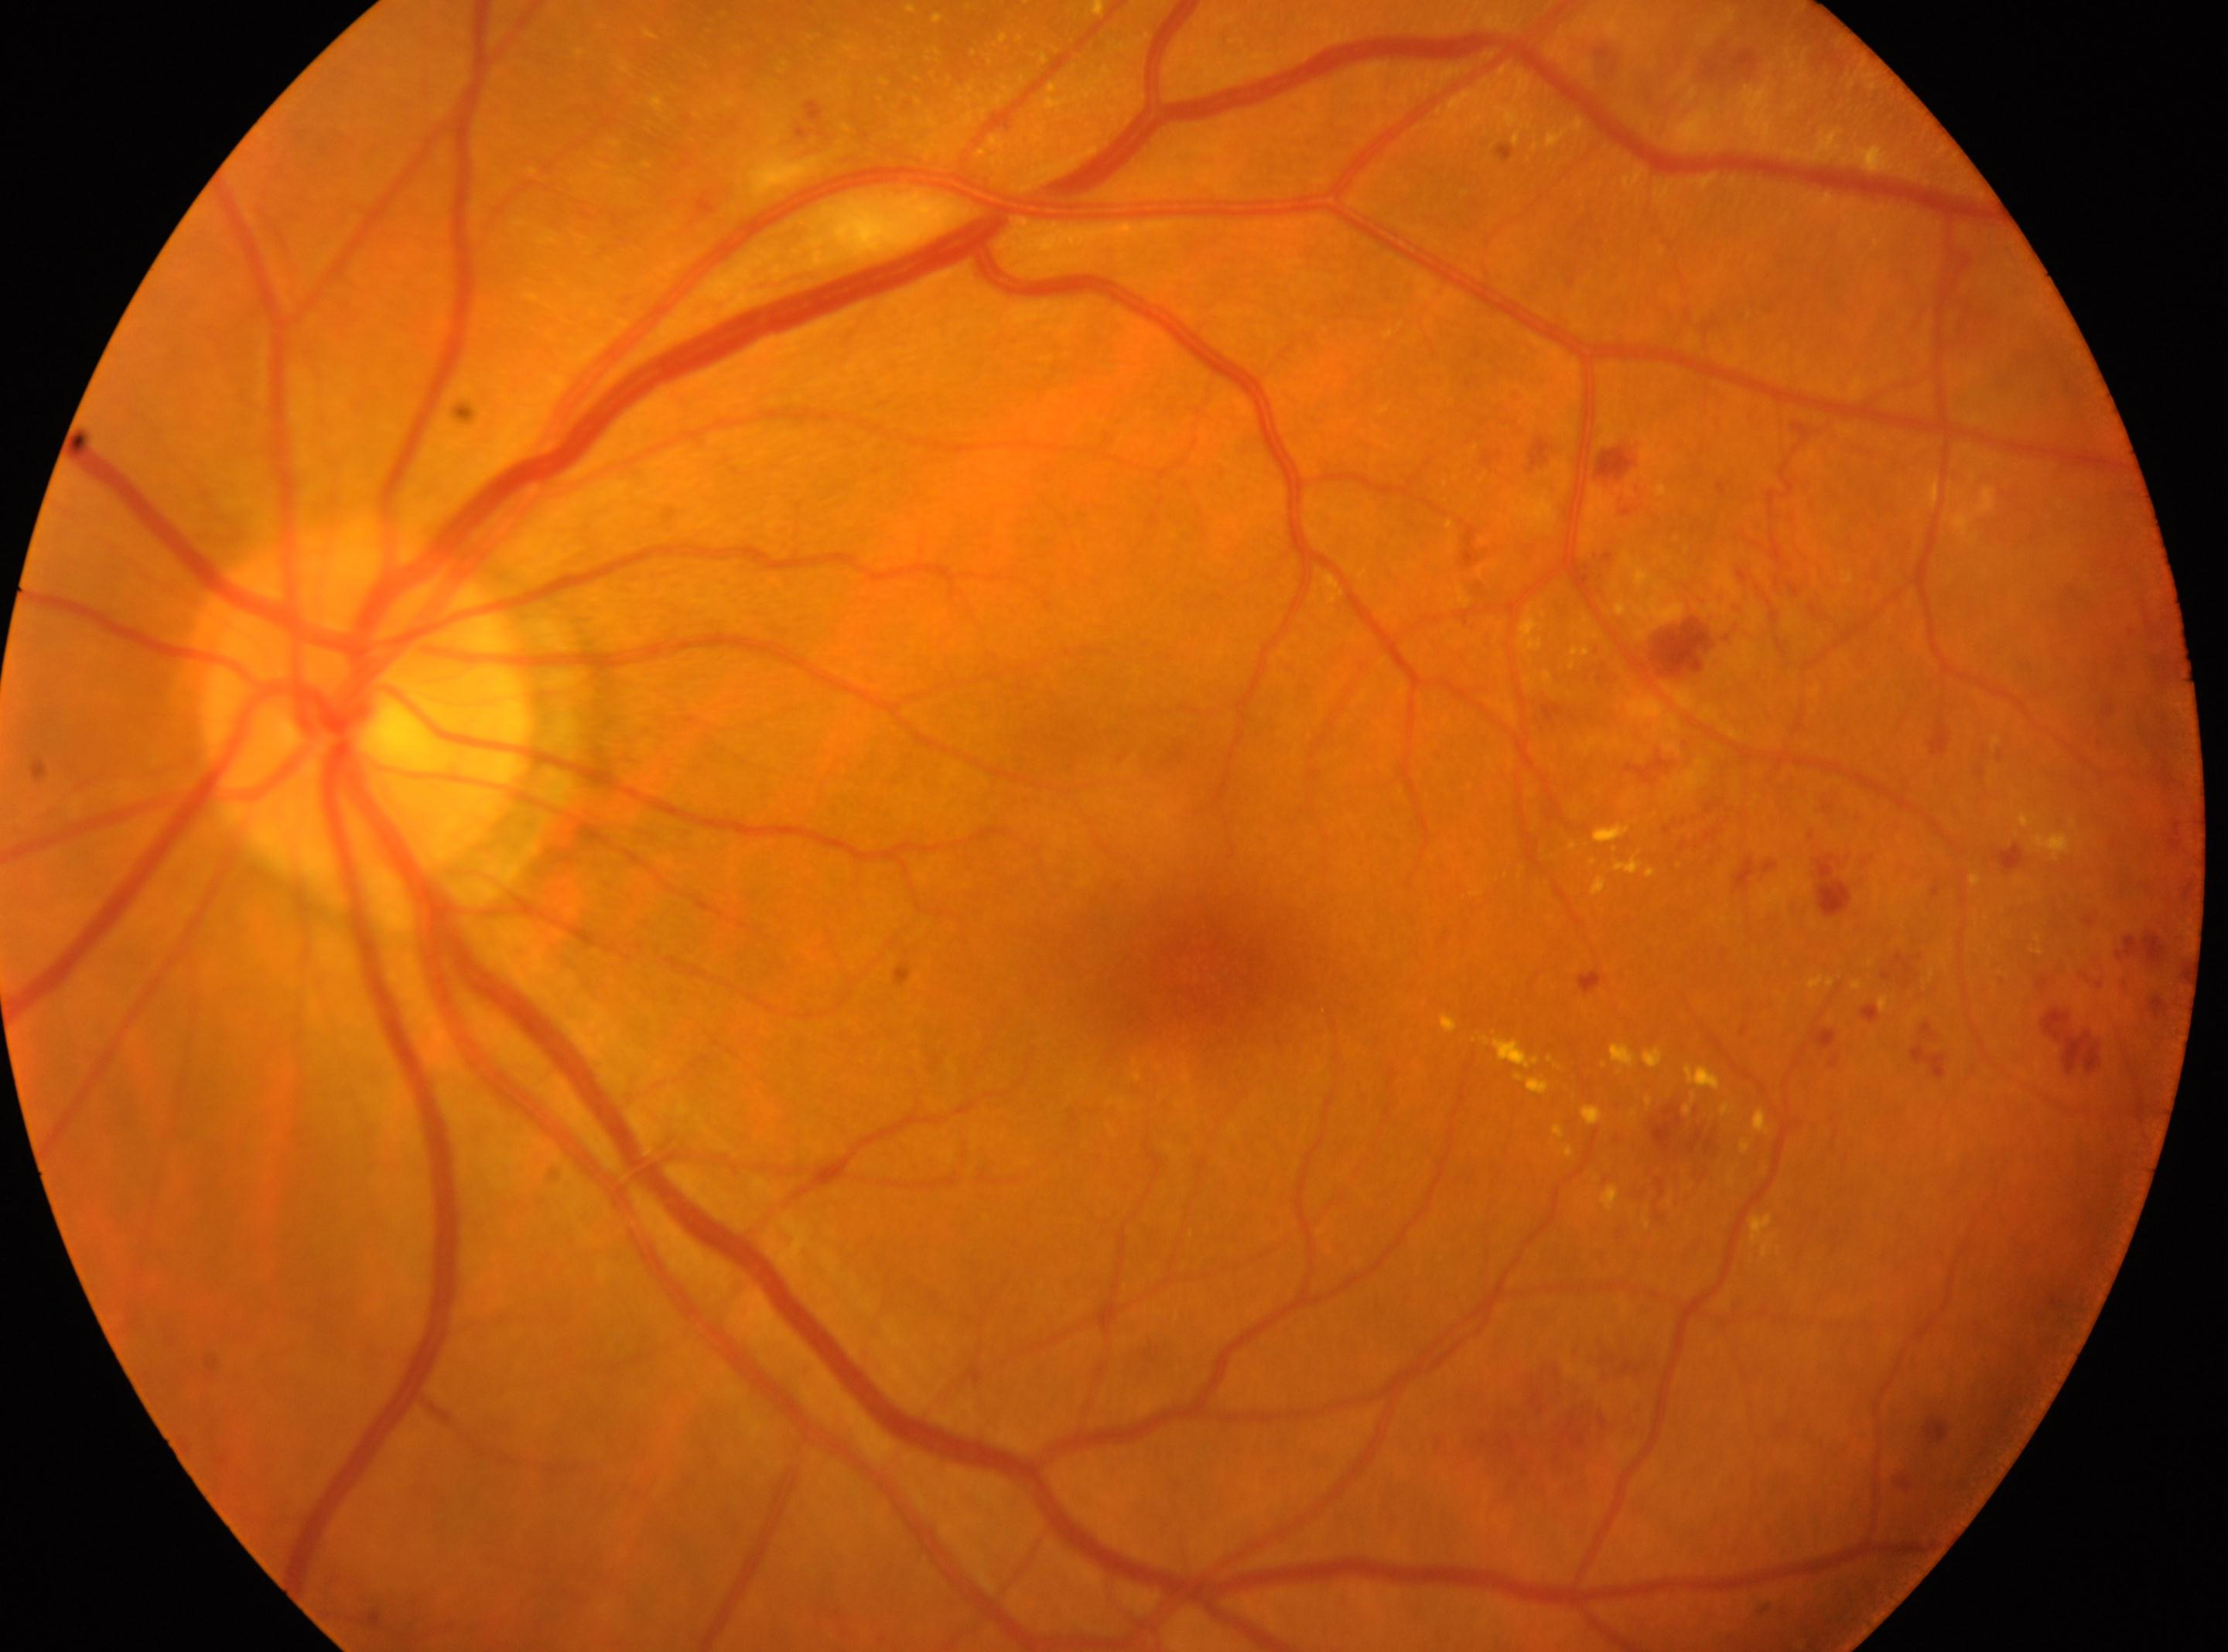 – foveal center — (1194,967)
– the optic disc — (367,712)
– laterality — oculus sinister
– DR severity — grade 2 (moderate NPDR)